Retinal fundus photograph. 45° FOV. 2352 by 1568 pixels — 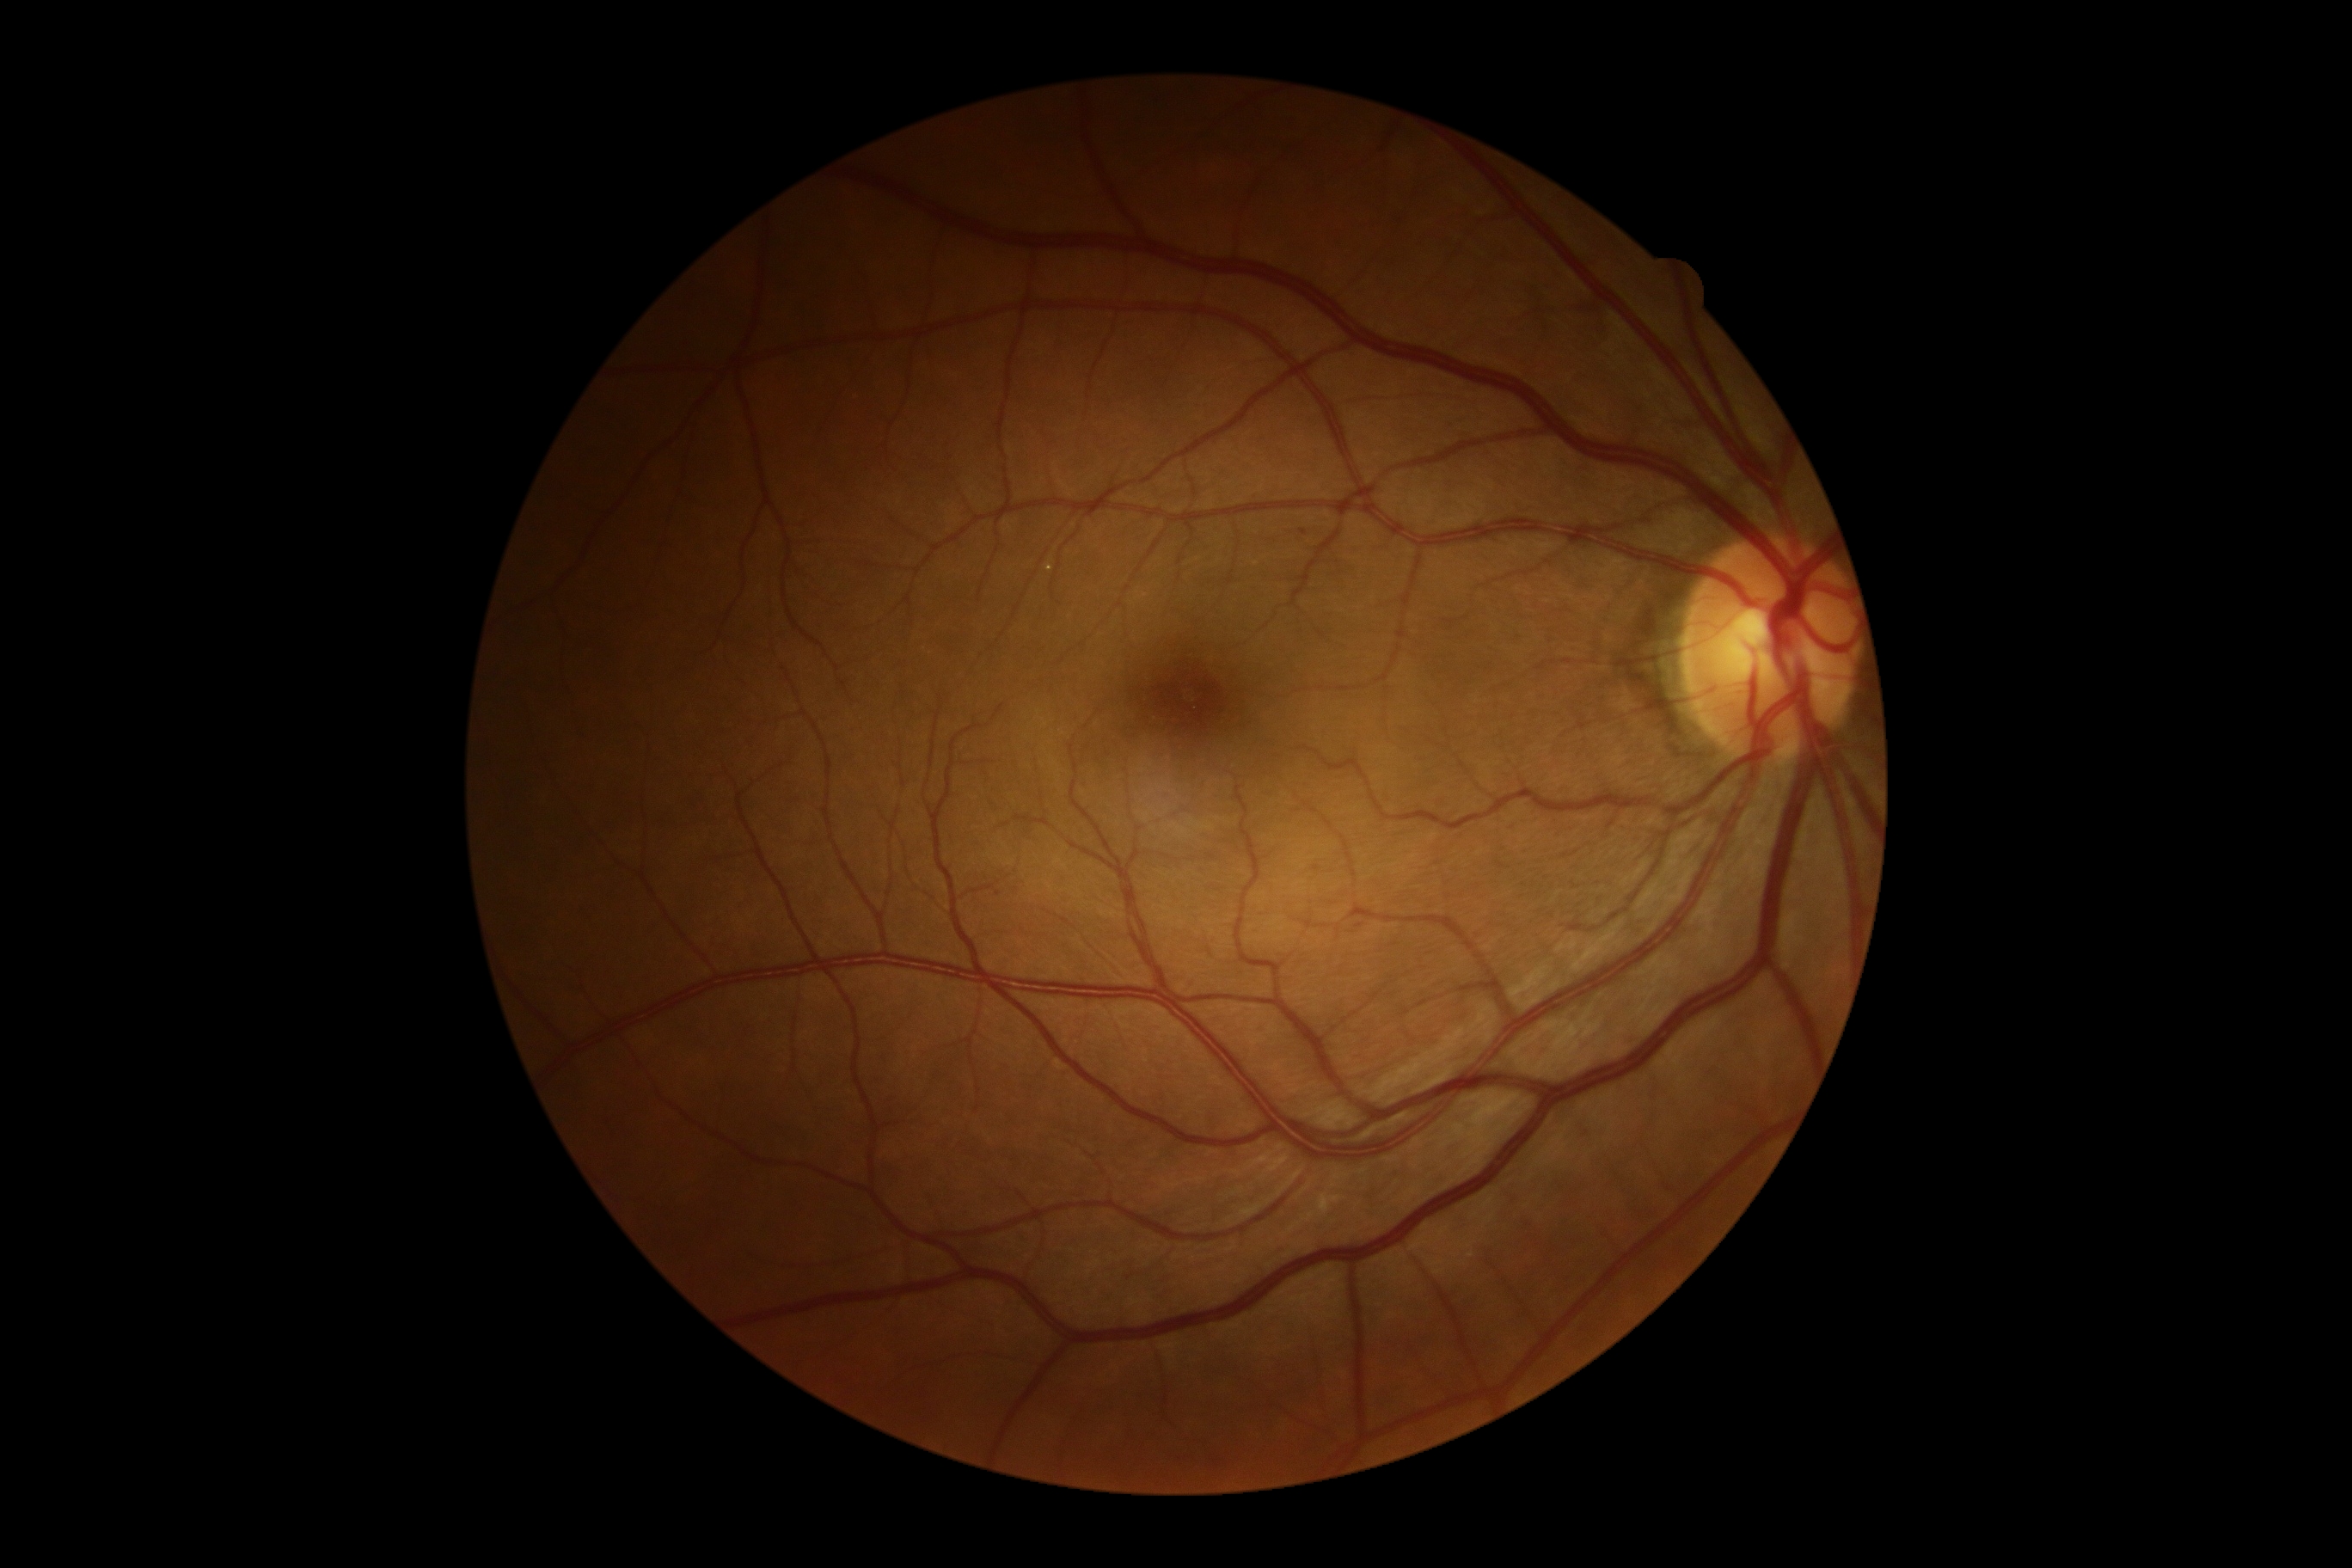 diabetic retinopathy = grade 1 (mild NPDR); DR class = non-proliferative diabetic retinopathy.